Color fundus photograph: 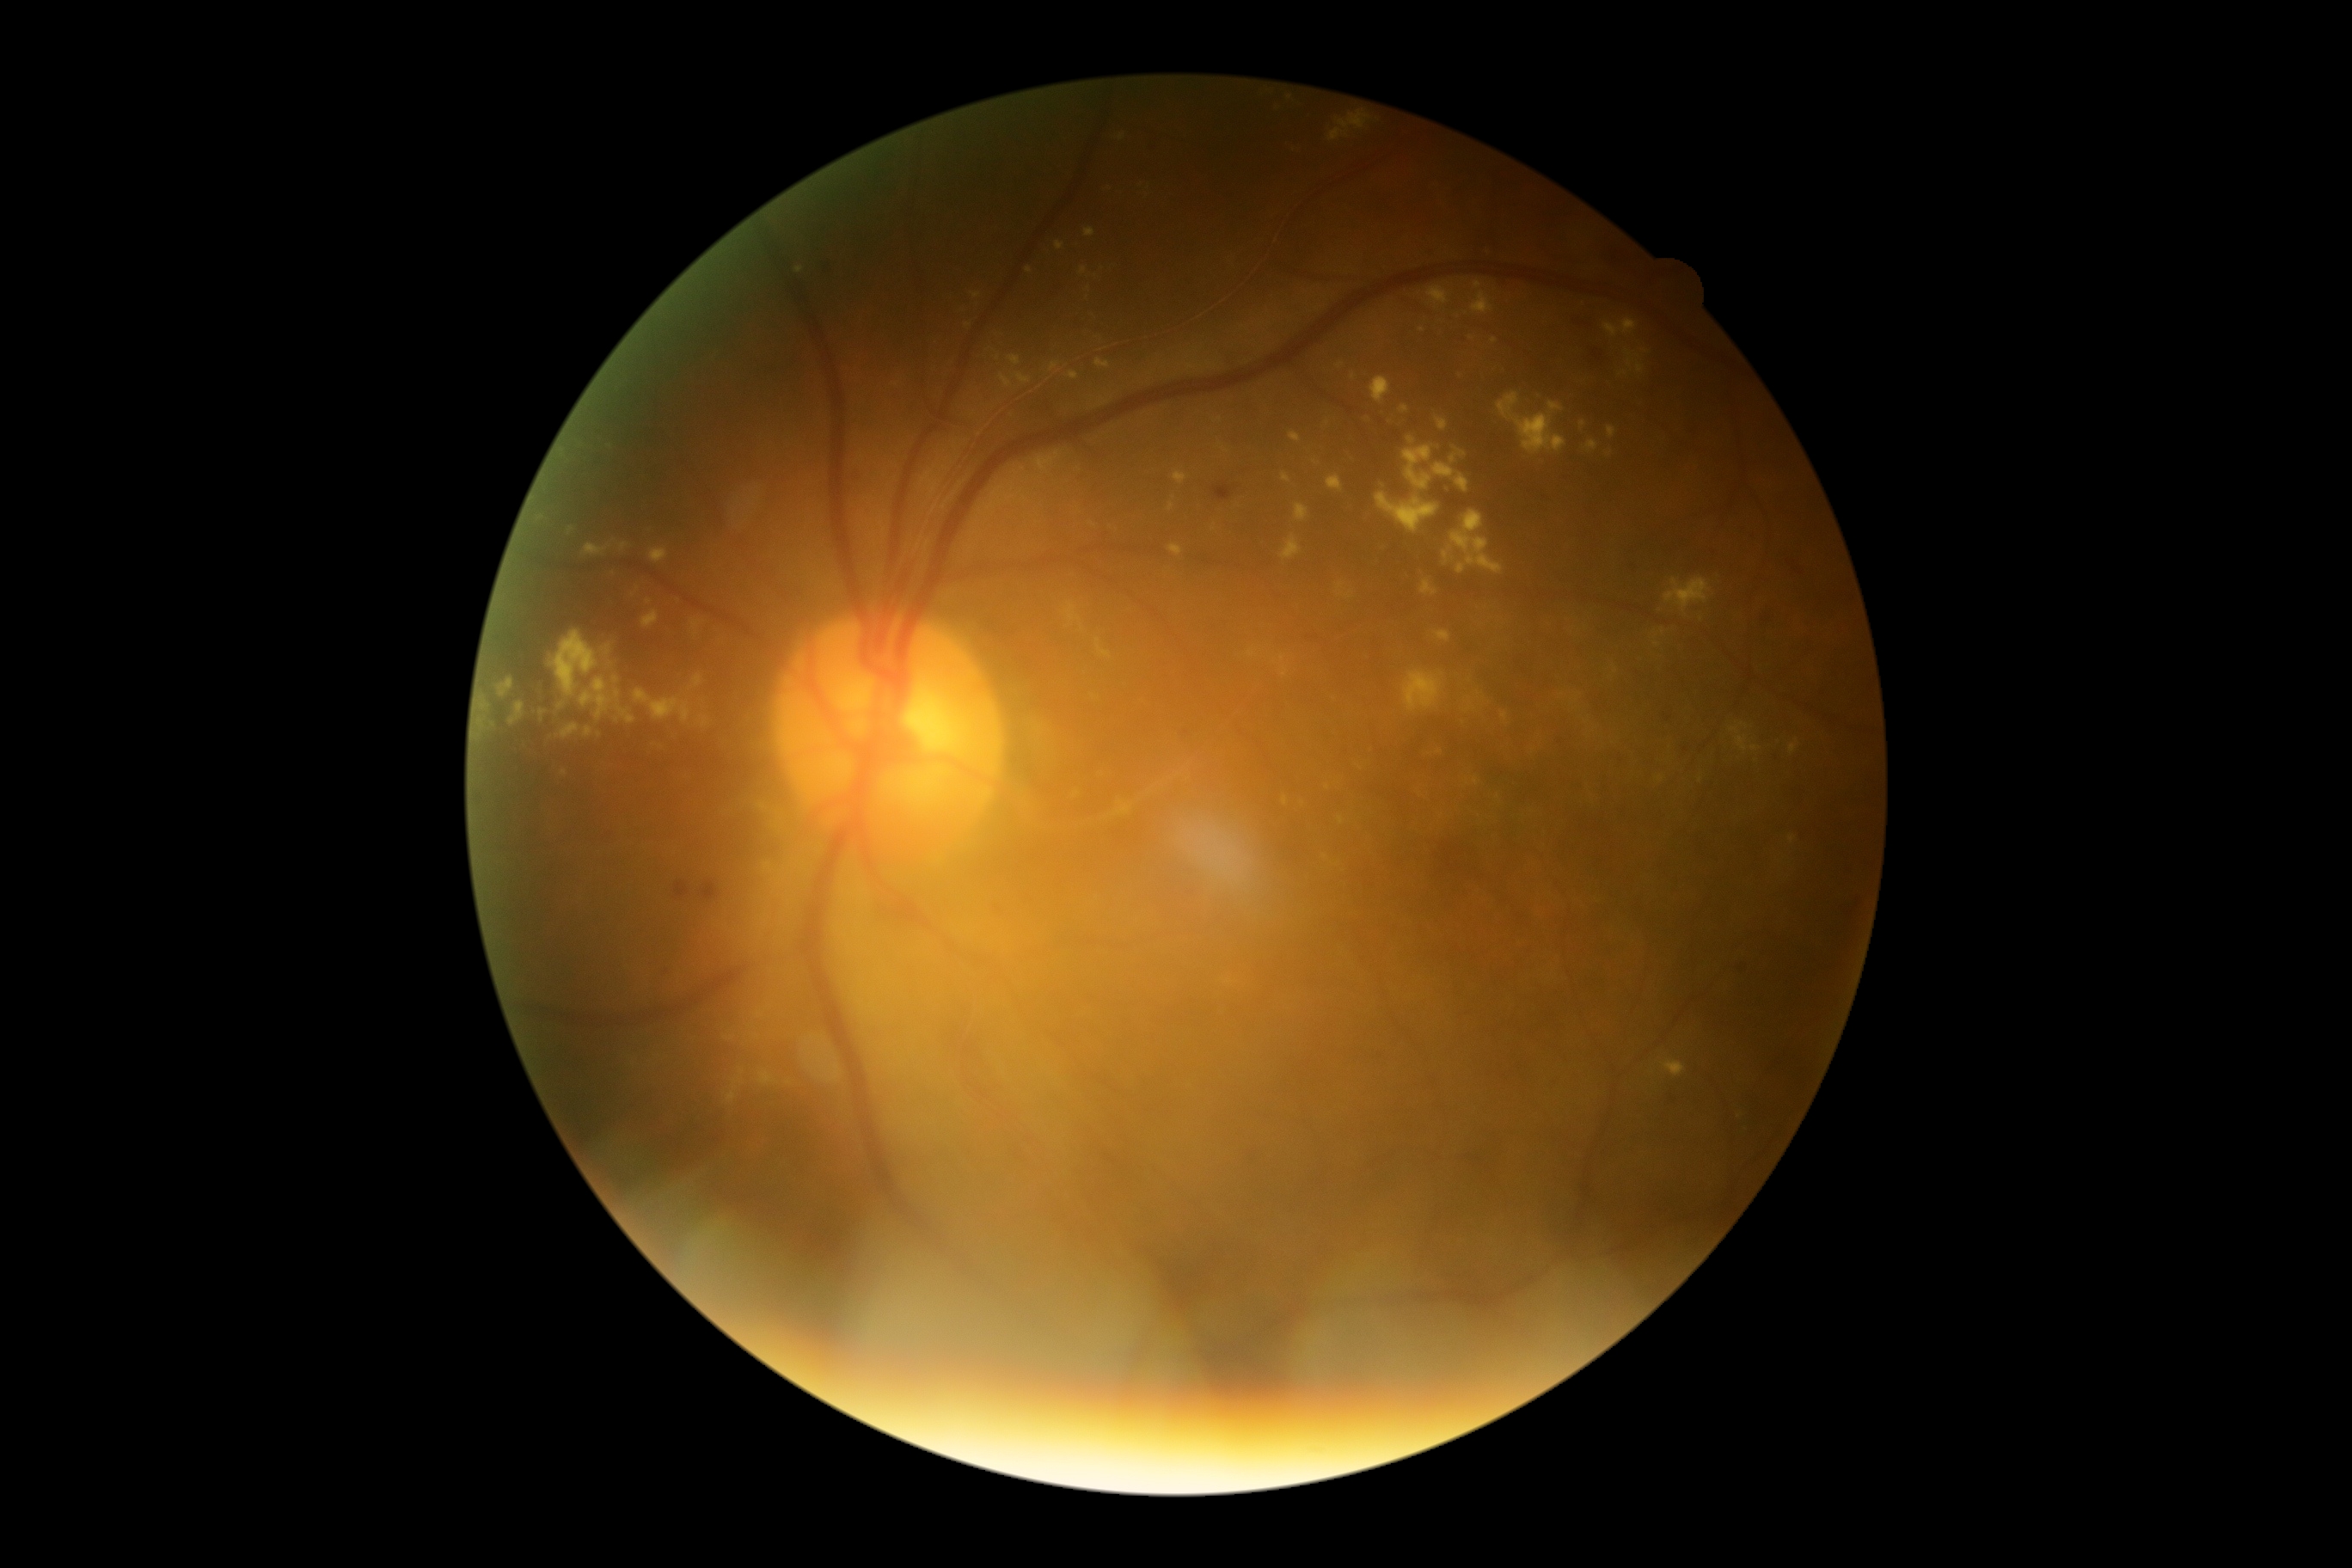

Diabetic retinopathy severity is grade 2.